Wide-field fundus image from infant ROP screening; 1240x1240px — 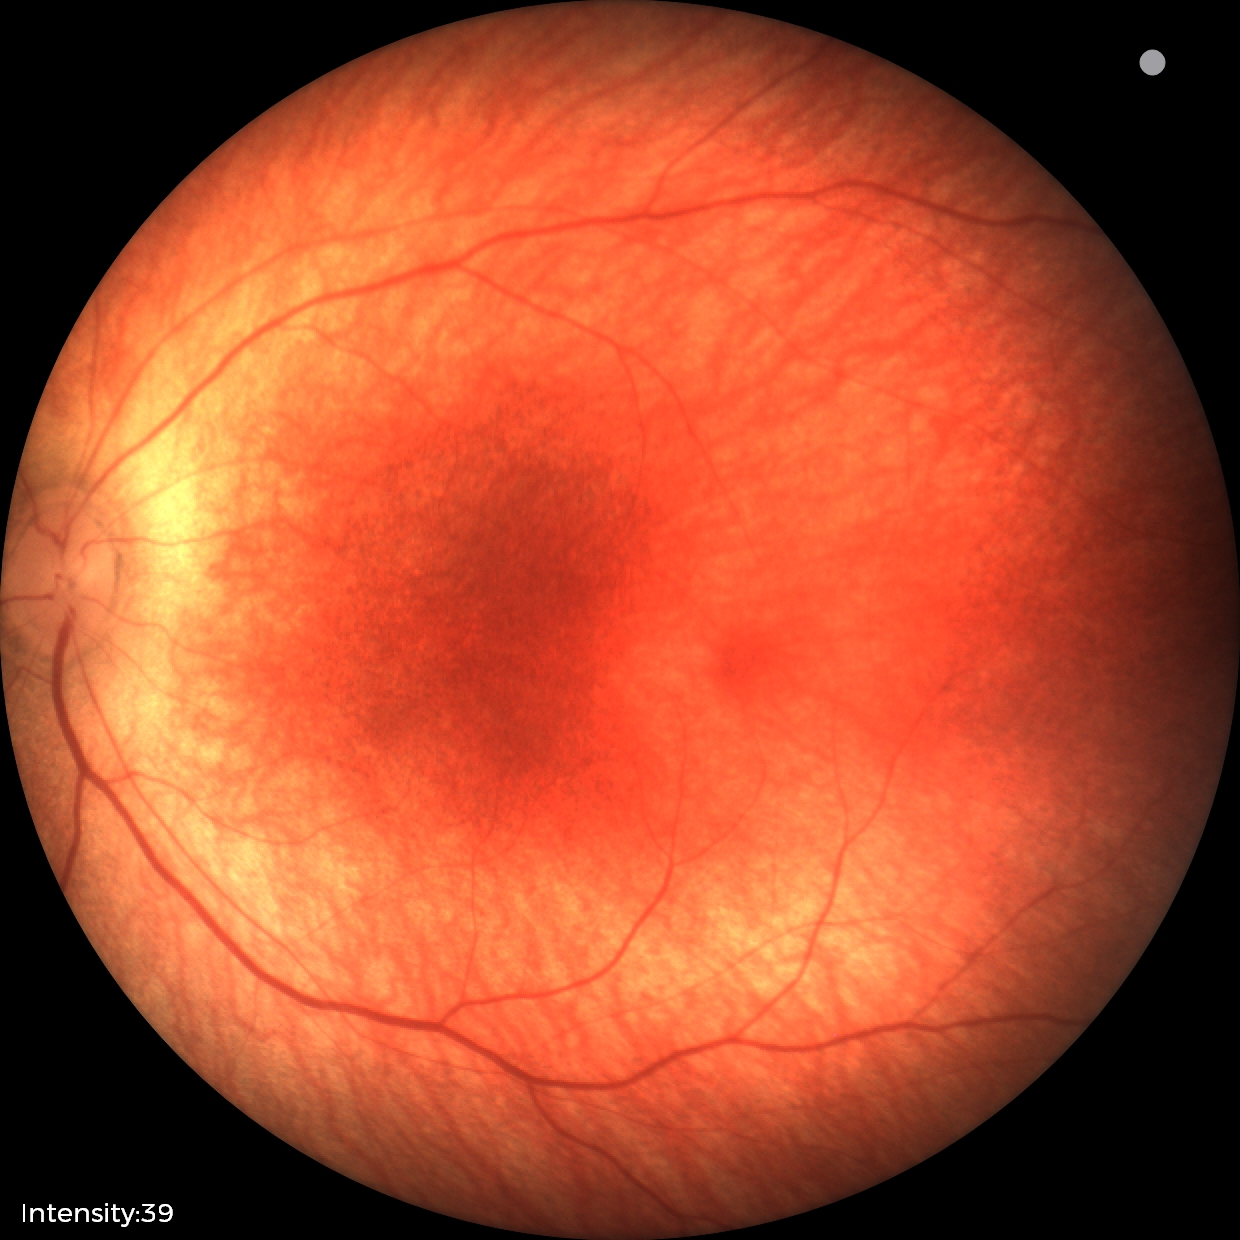

Screening examination diagnosed as physiological.